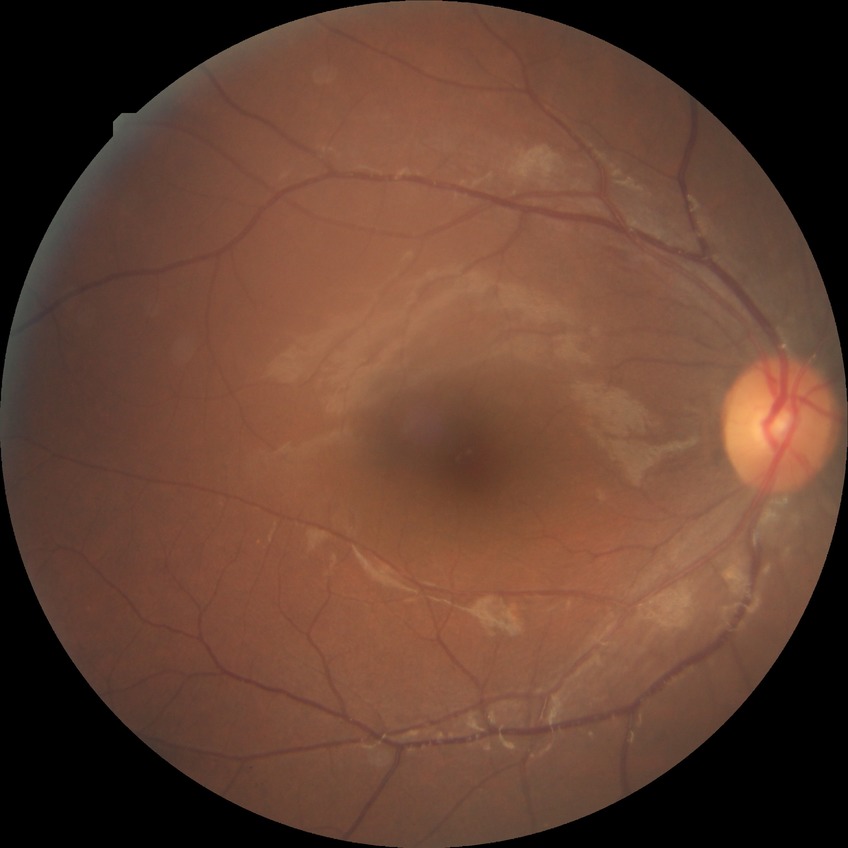 Davis grading is simple diabetic retinopathy.